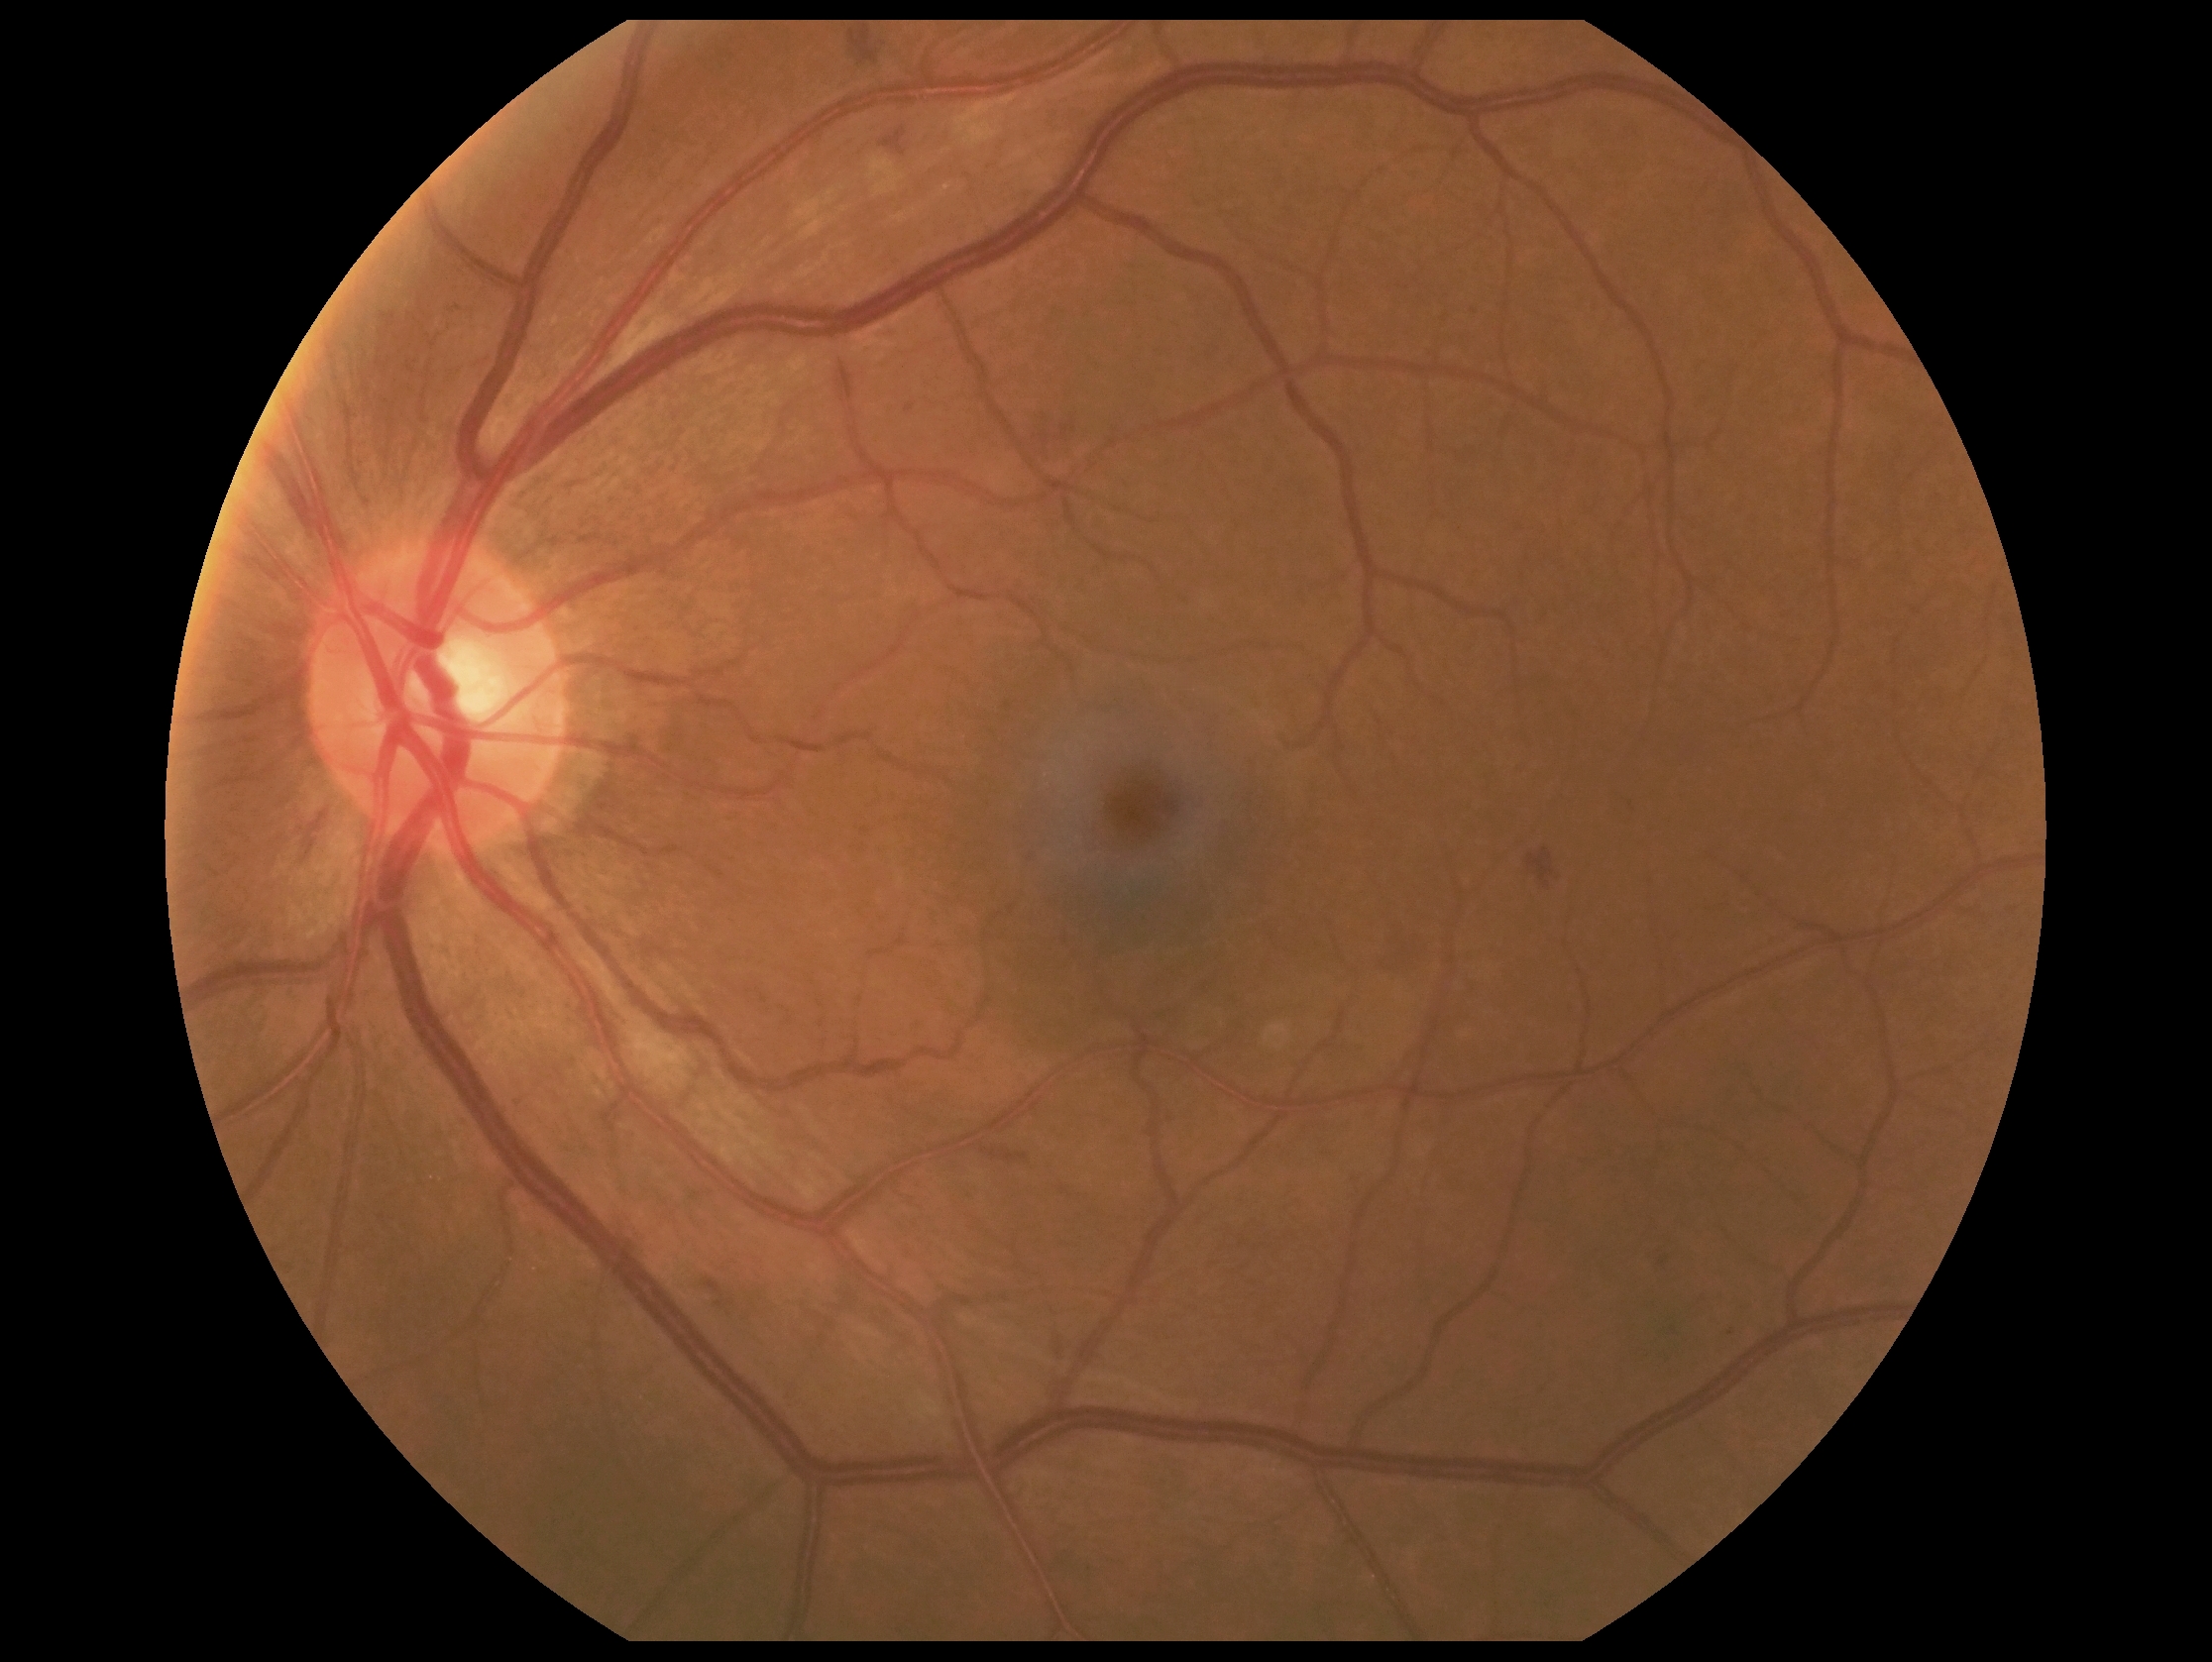
* DR class — non-proliferative diabetic retinopathy
* diabetic retinopathy severity — moderate NPDR (grade 2)